640 by 480 pixels · infant wide-field retinal image: 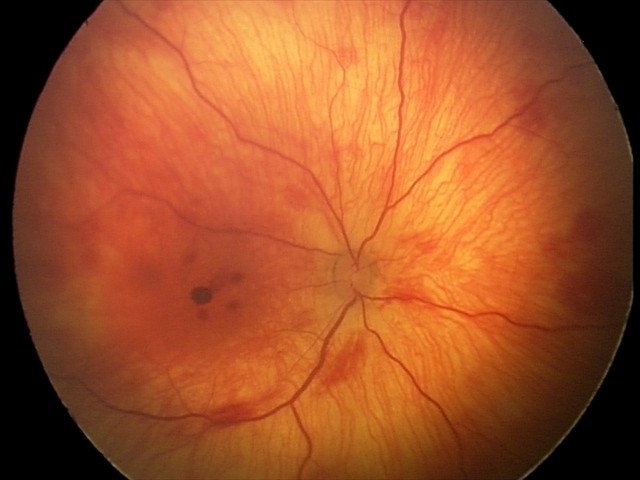

Series diagnosed as retinal hemorrhages.